1924x1556px. Wide-field retinal mosaic image. 200-degree field of view:
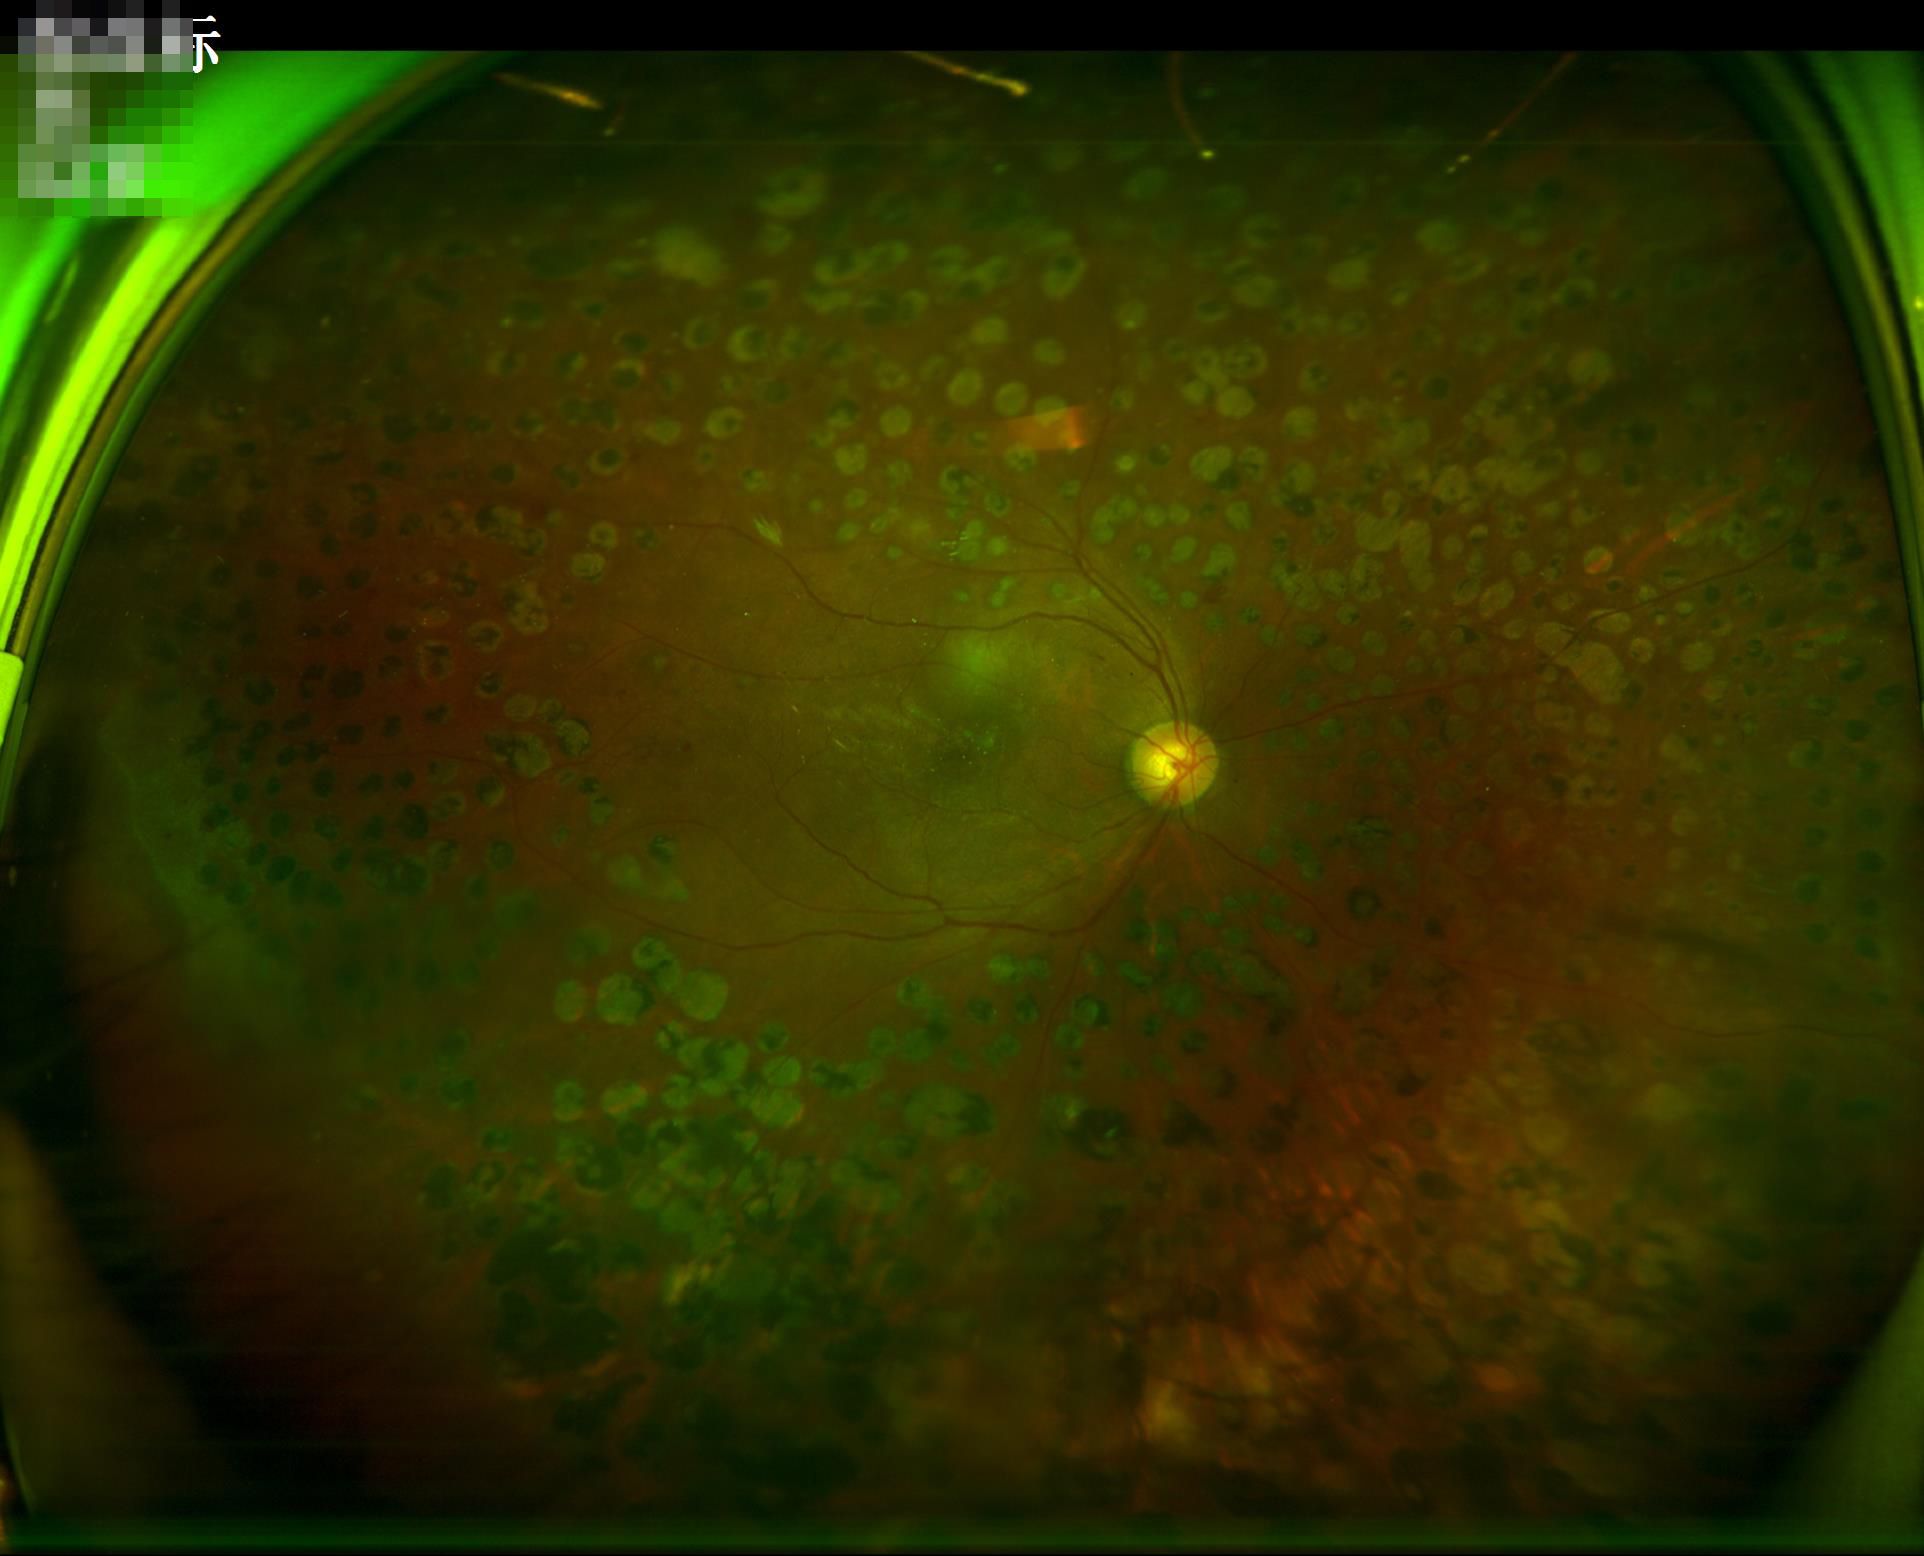
Overall image quality is good. Adequate contrast for distinguishing structures. Image is sharp throughout the field.